RetCam wide-field infant fundus image. 1440x1080. Natus RetCam Envision, 130° FOV
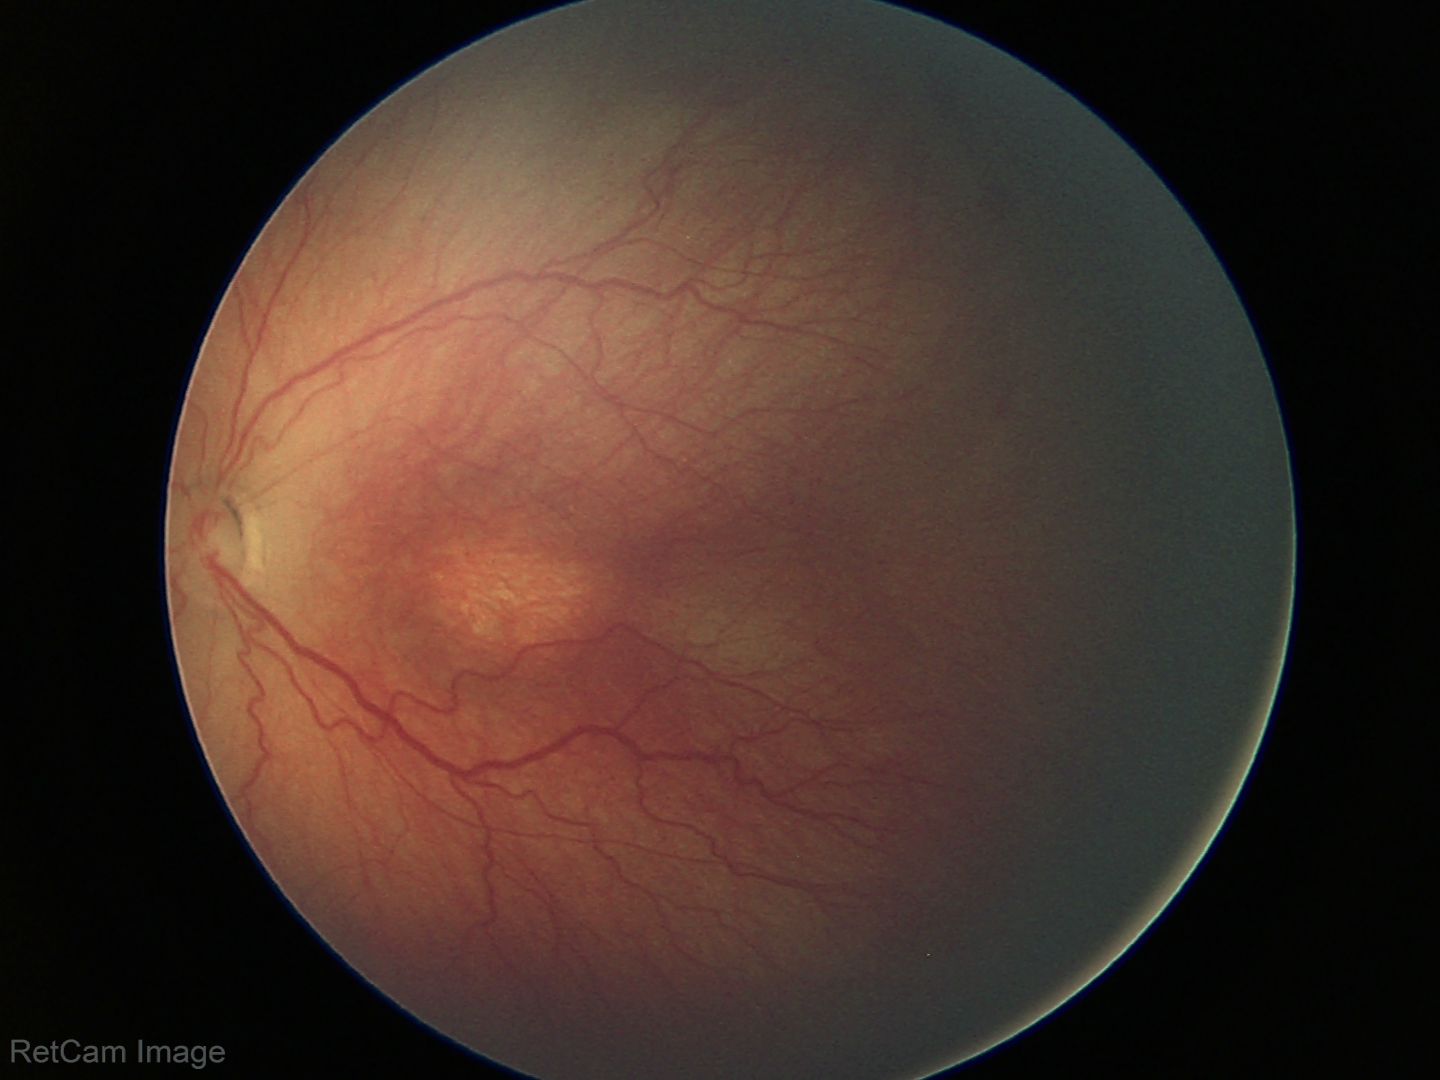

Diagnosis from this screening exam: retinopathy of prematurity stage 3. Without plus disease.